Infant wide-field retinal image:
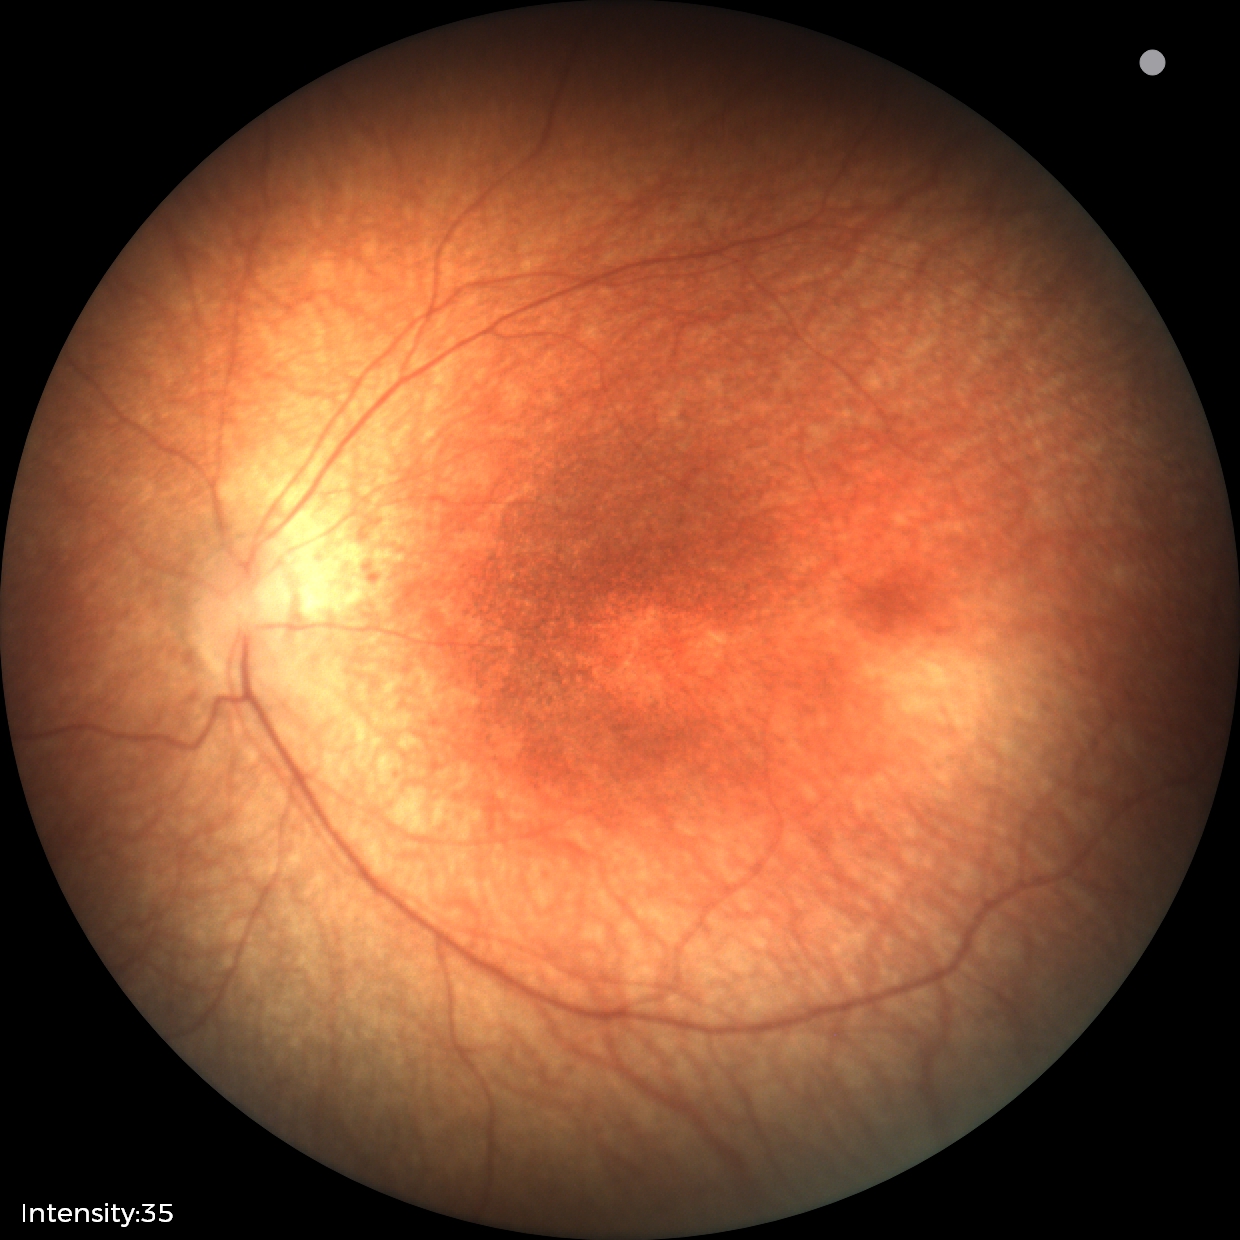
Impression: normal retinal appearance.